Captured on a Topcon TRC-NW400 fundus camera; patient age: 41 years; refractive error: -0.25 -0.5 x 179; sex: female
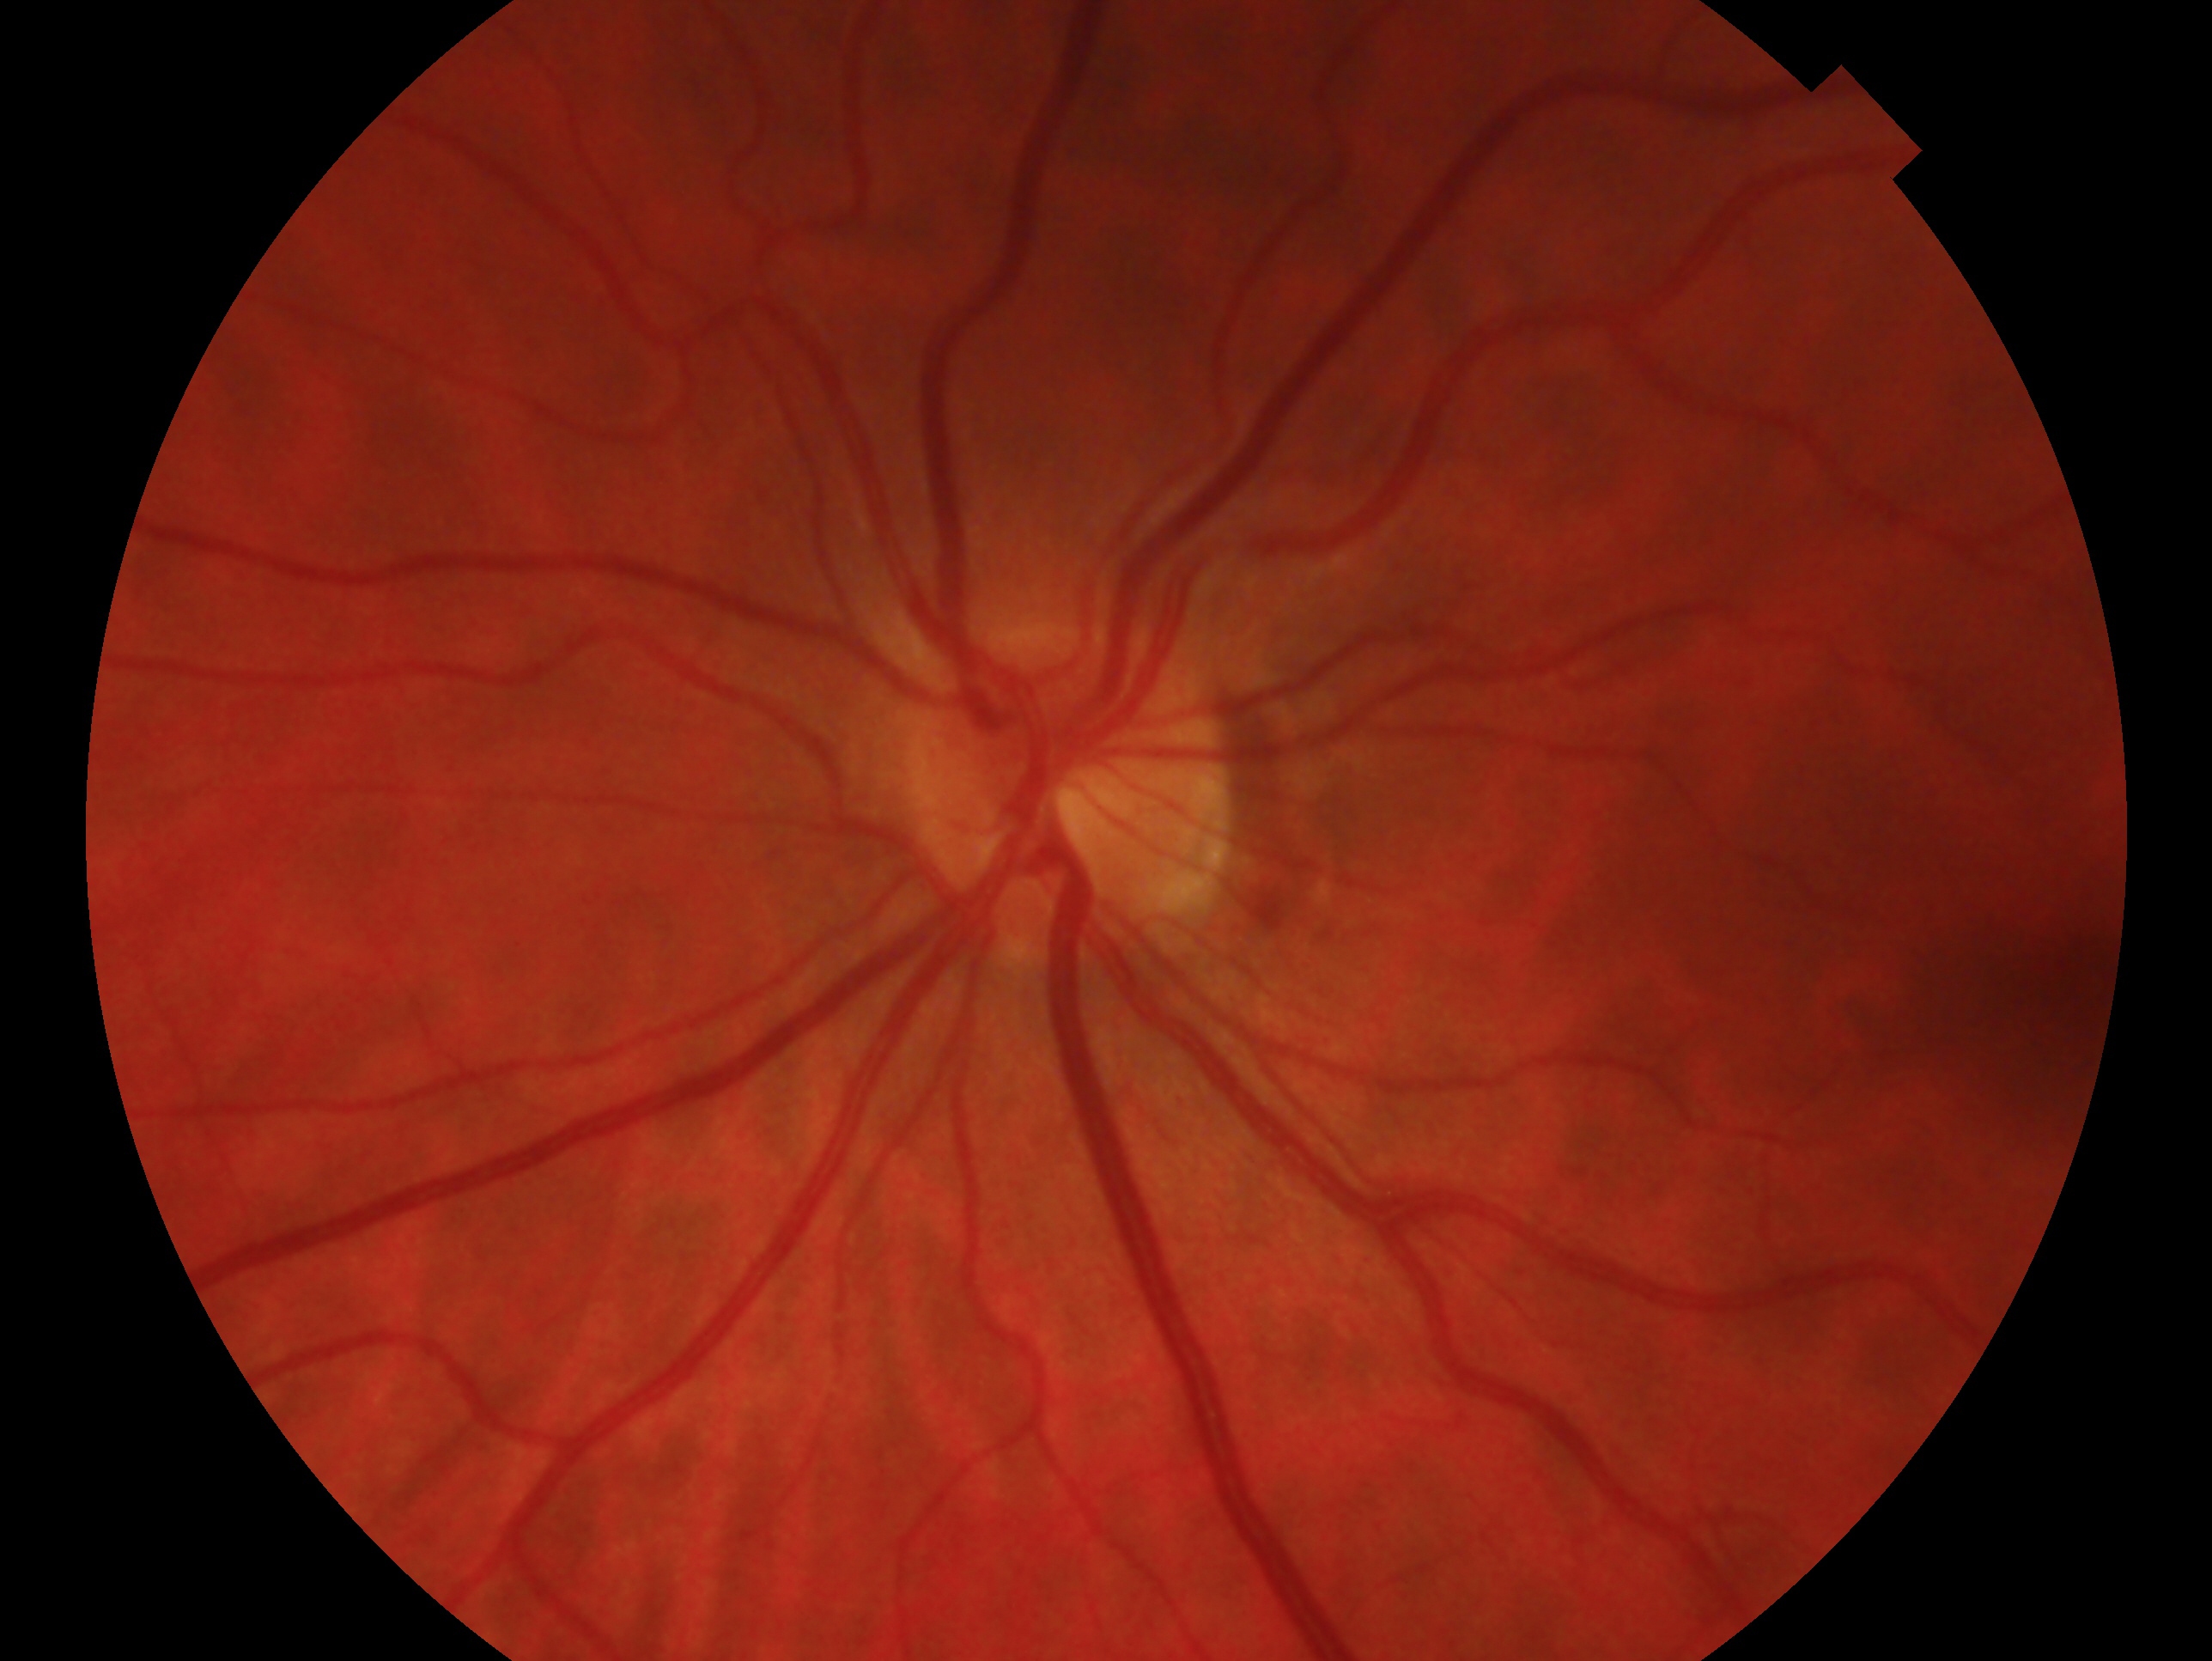 Findings:
* assessment: negative for glaucoma
* laterality: left eye